CFP, FOV: 45 degrees, 1932x1916px
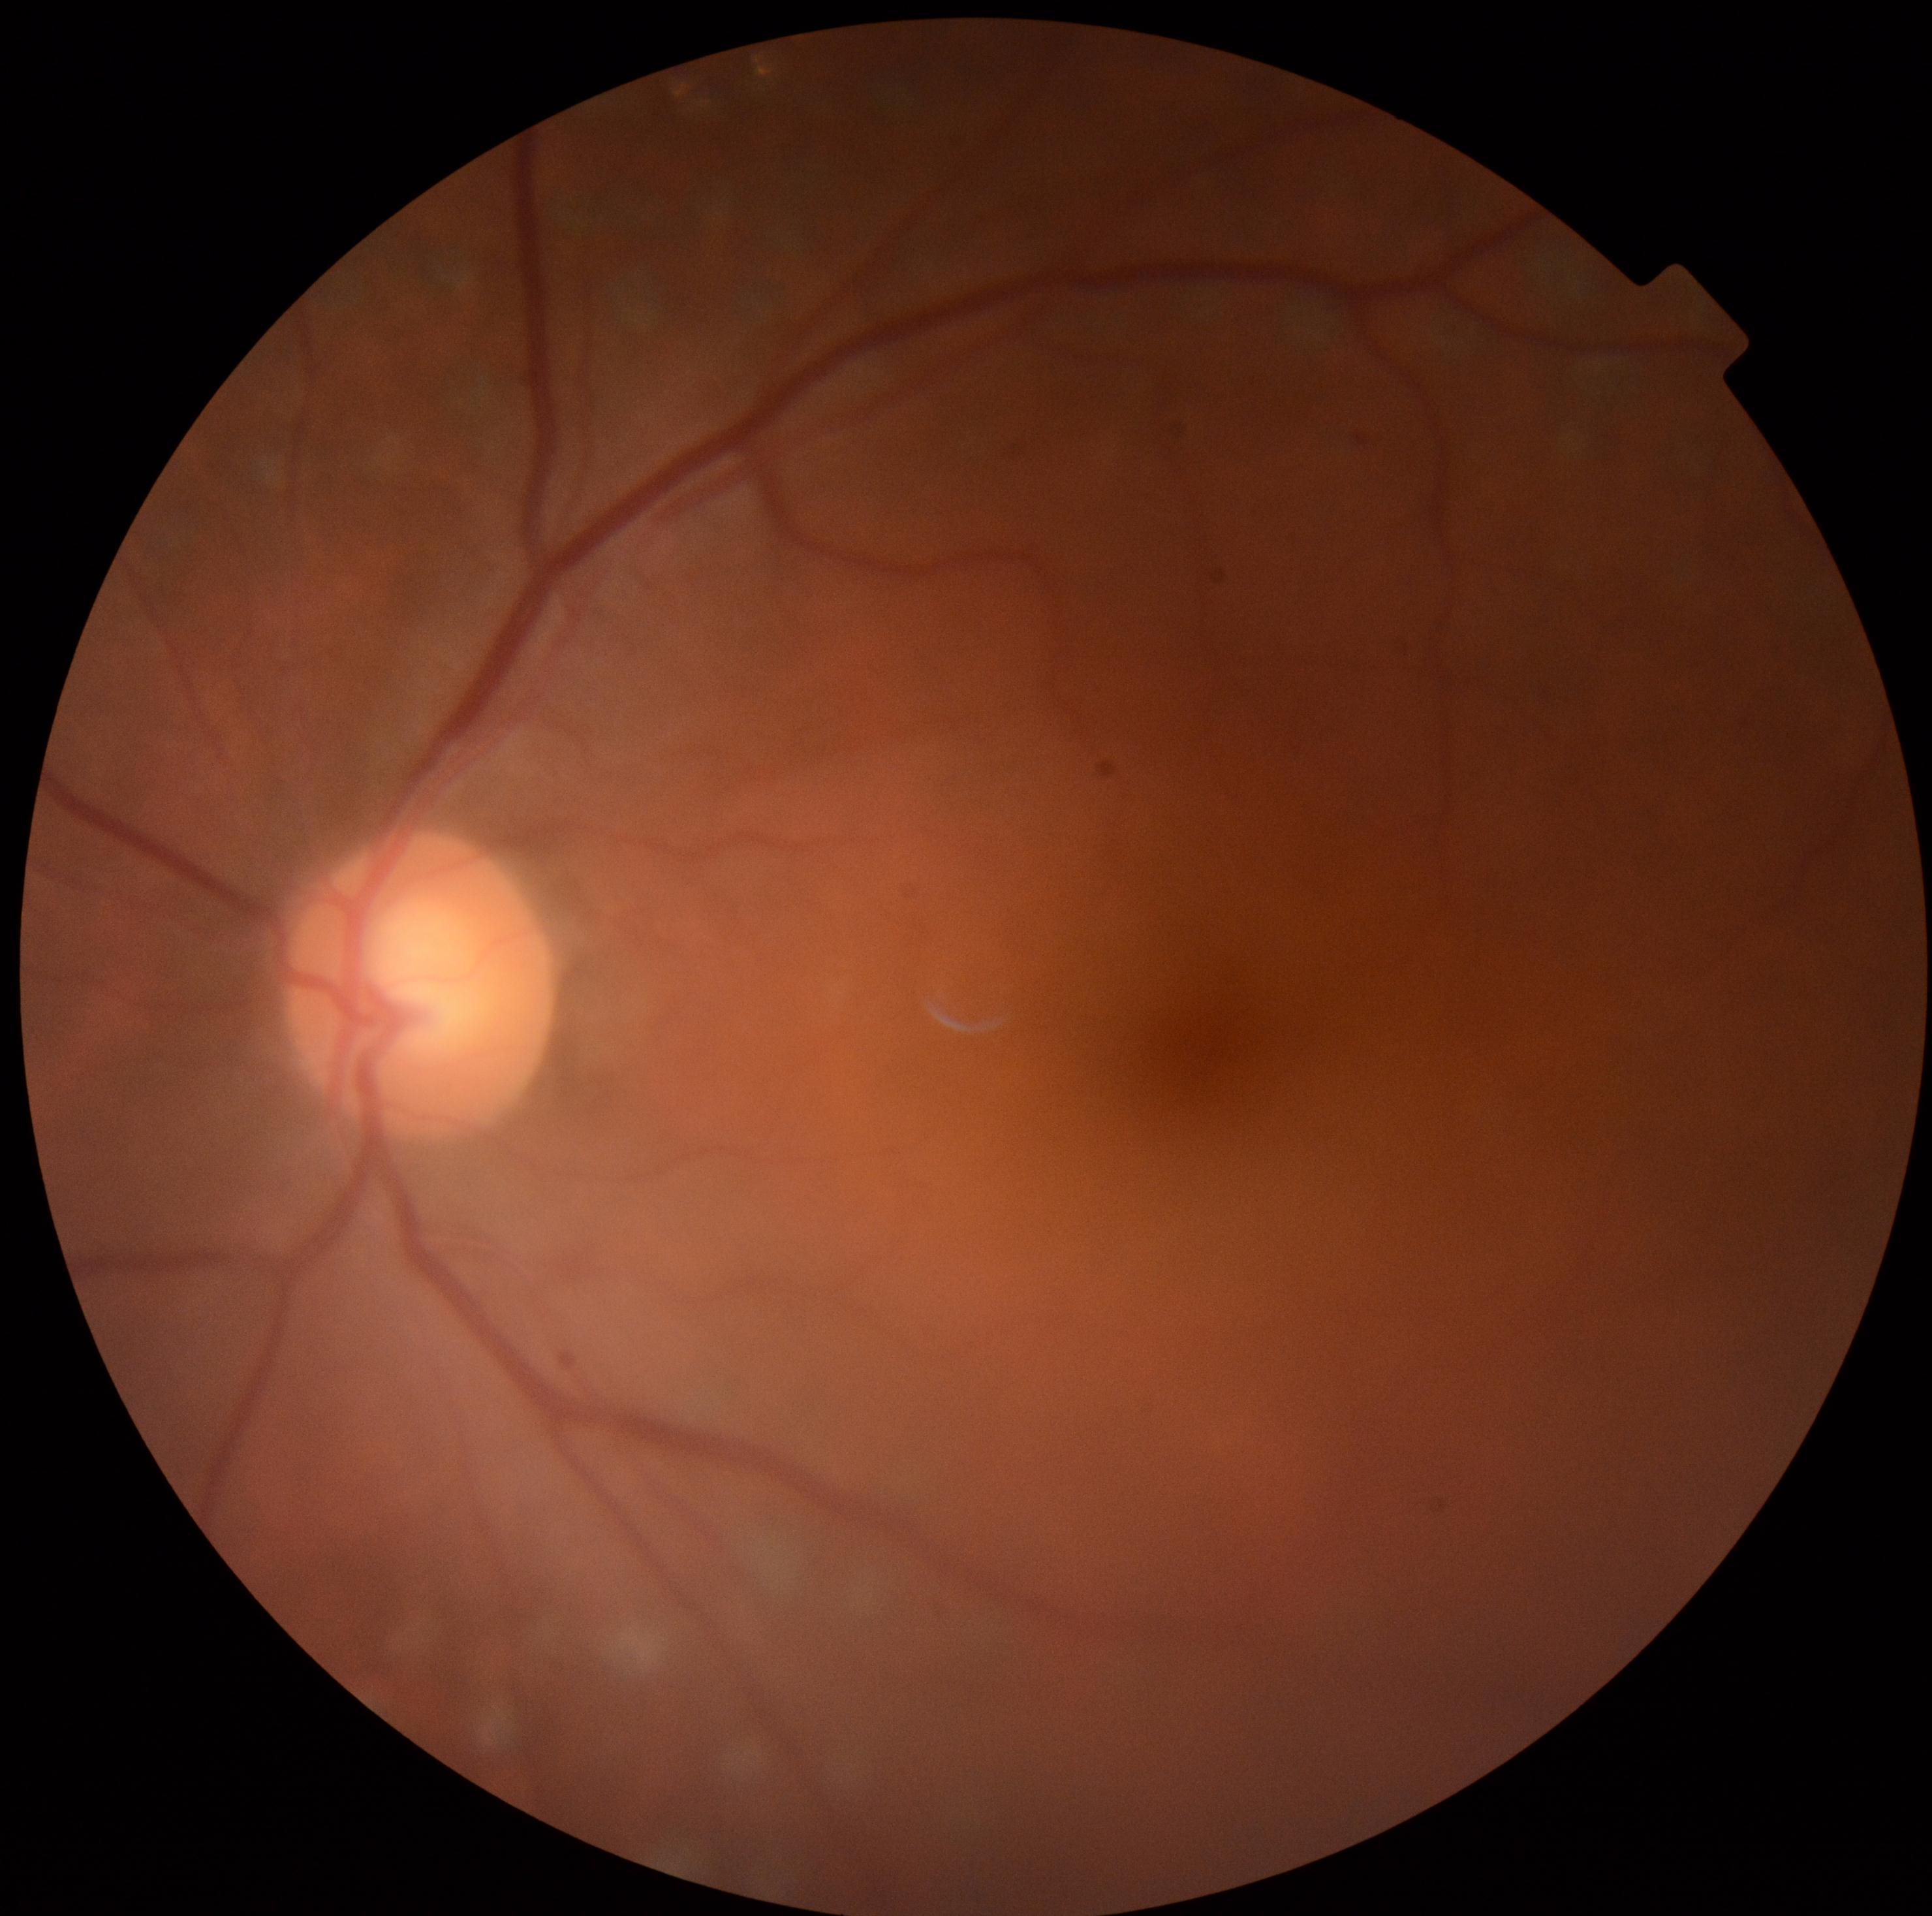
Findings:
* DR stage — 0/4